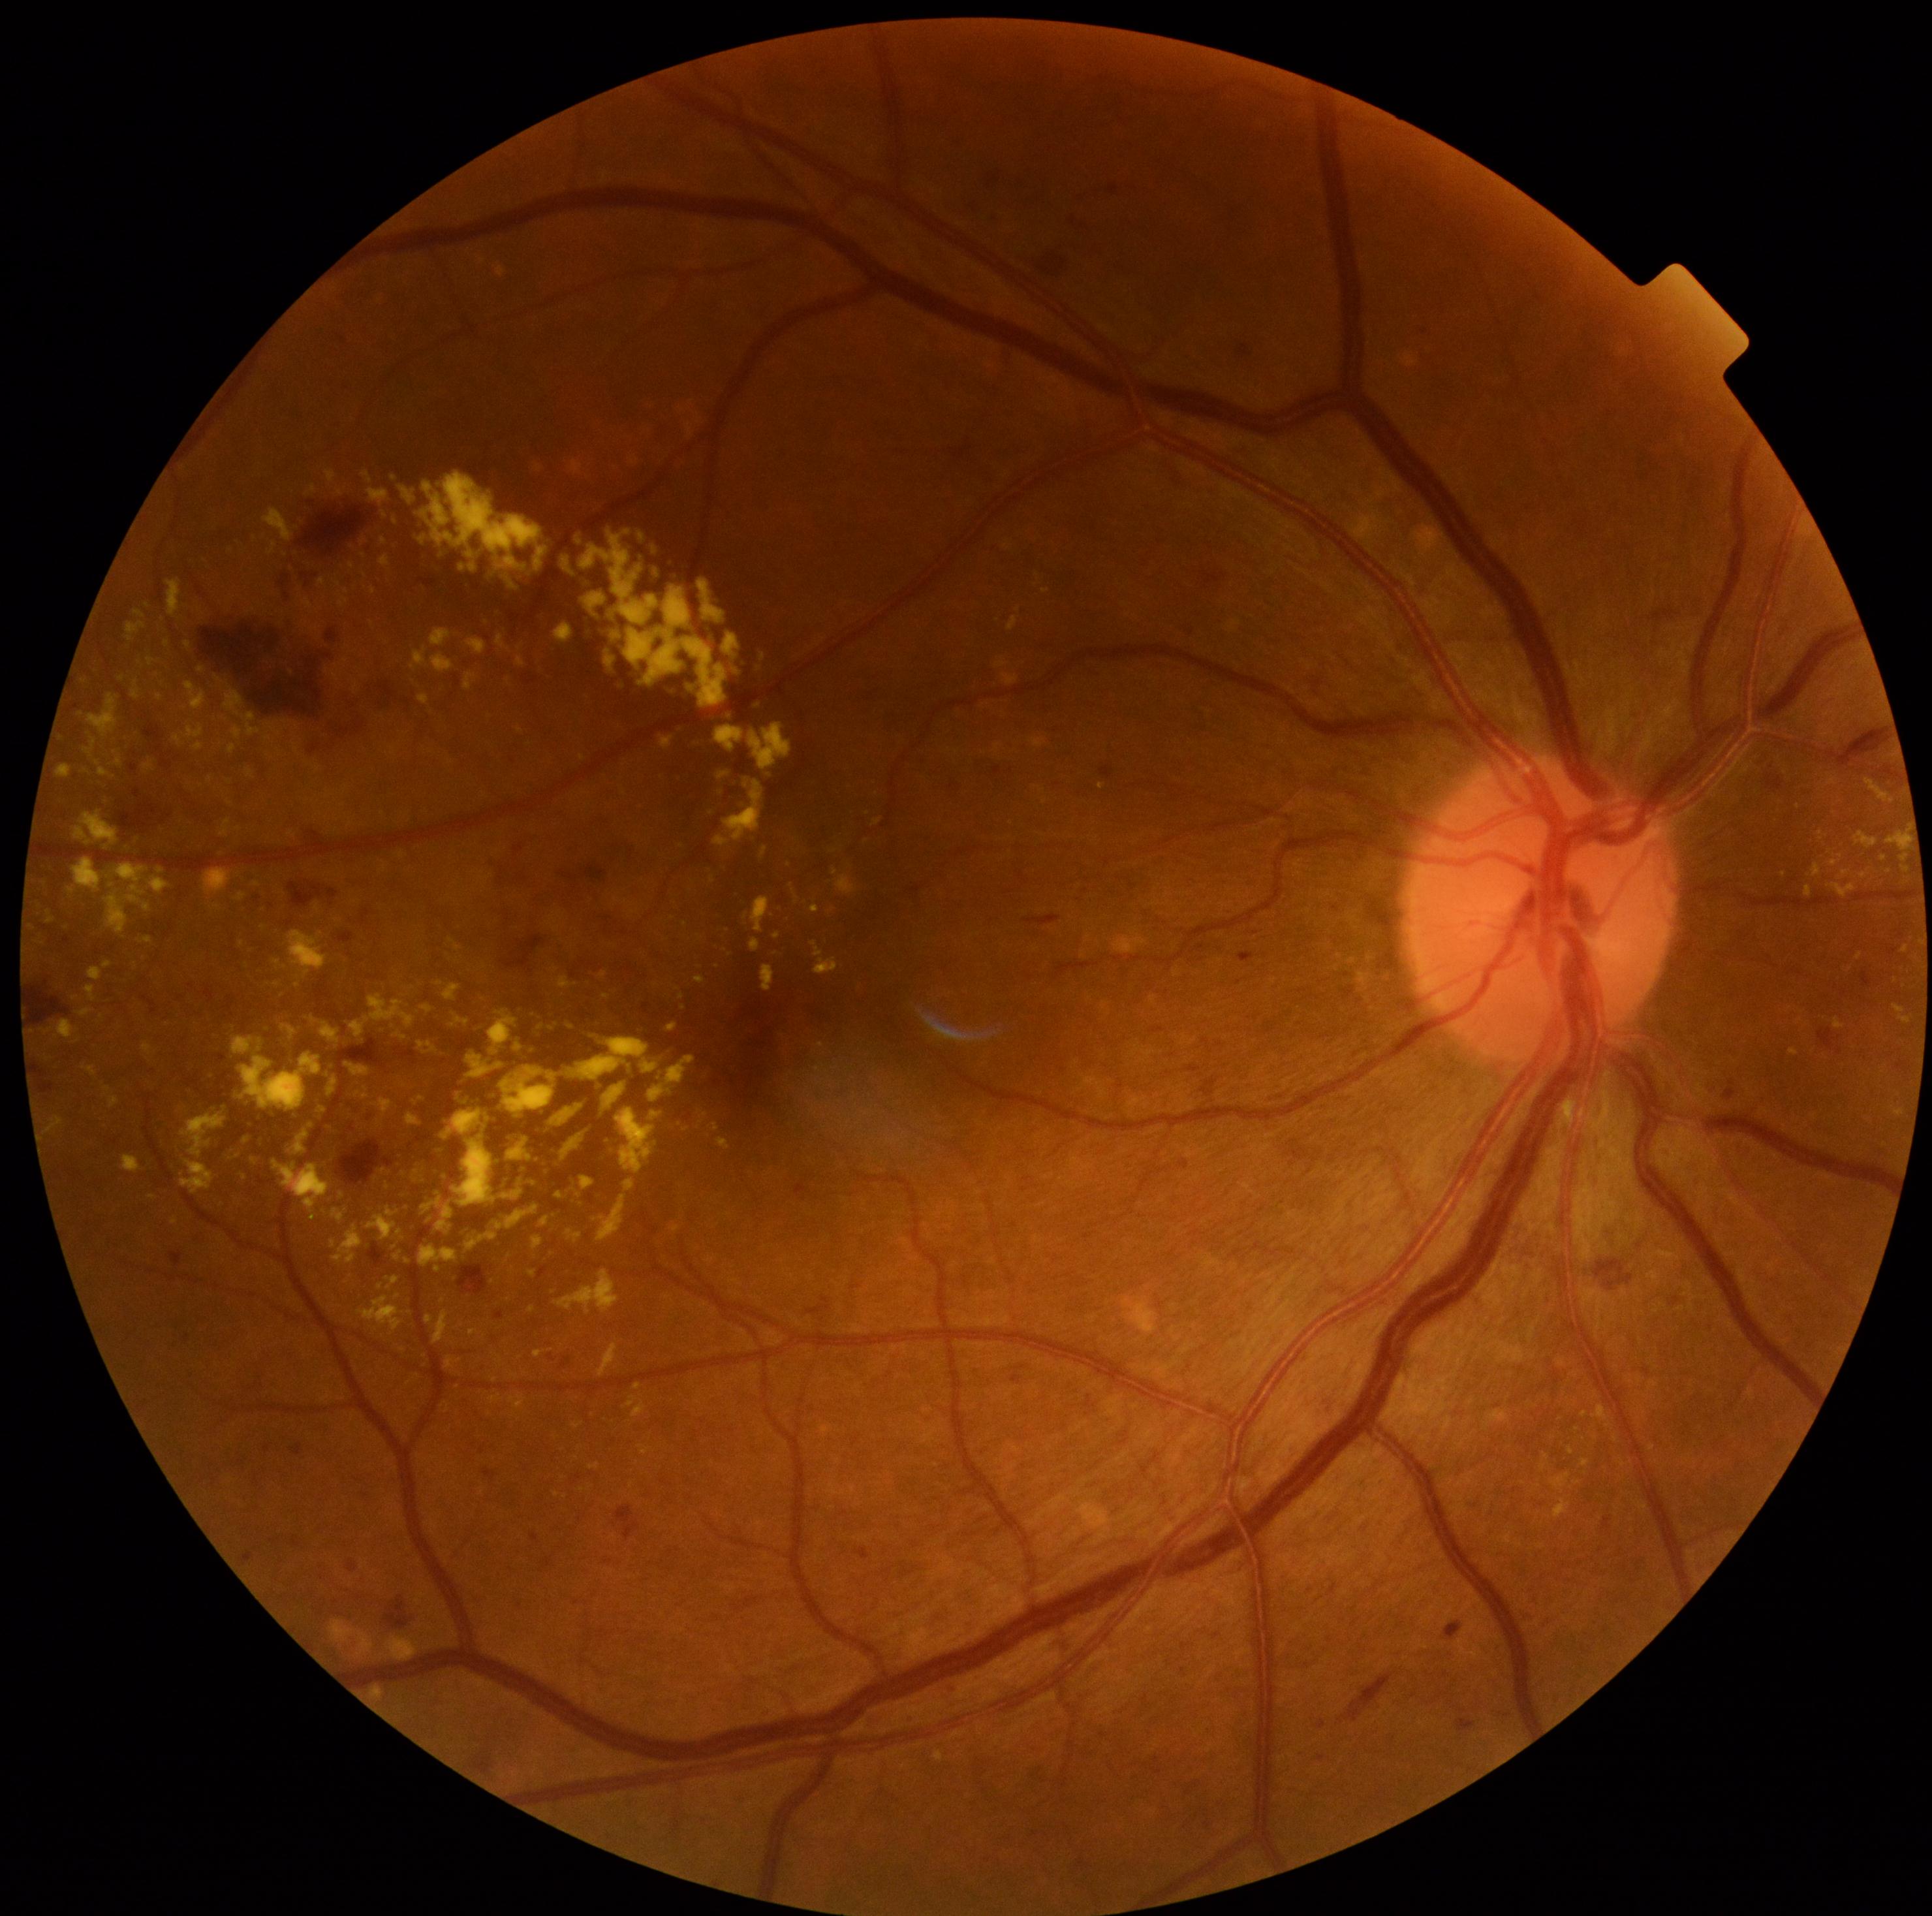 Diabetic retinopathy: 2
A subset of detected lesions:
* microaneurysms (more not shown): [left=264, top=1443, right=273, bottom=1453], [left=1446, top=1622, right=1461, bottom=1640], [left=1182, top=1644, right=1190, bottom=1649], [left=1187, top=1064, right=1200, bottom=1073], [left=522, top=672, right=538, bottom=685], [left=854, top=1547, right=870, bottom=1560], [left=326, top=628, right=339, bottom=642], [left=1313, top=680, right=1322, bottom=685], [left=339, top=932, right=354, bottom=943], [left=347, top=1560, right=358, bottom=1573], [left=613, top=1505, right=642, bottom=1541], [left=1673, top=1296, right=1681, bottom=1307], [left=420, top=576, right=438, bottom=589], [left=515, top=846, right=524, bottom=855], [left=1887, top=945, right=1900, bottom=956]
* soft exudates: absent
* hard exudates (more not shown): [left=717, top=1139, right=730, bottom=1150], [left=596, top=1195, right=626, bottom=1242], [left=464, top=671, right=478, bottom=691], [left=425, top=1316, right=434, bottom=1323], [left=790, top=885, right=798, bottom=898], [left=582, top=790, right=591, bottom=798], [left=1887, top=833, right=1909, bottom=851], [left=600, top=971, right=608, bottom=978], [left=364, top=1000, right=695, bottom=1268], [left=1839, top=870, right=1850, bottom=880], [left=165, top=580, right=182, bottom=619], [left=1835, top=1020, right=1844, bottom=1029], [left=356, top=682, right=360, bottom=693], [left=132, top=680, right=142, bottom=701]
* Hard exudates (small, approximate centers) near x=297 y=727, x=713 y=880, x=201 y=669, x=1860 y=957, x=674 y=918, x=415 y=1103
* hemorrhages (more not shown): [left=37, top=1064, right=55, bottom=1094], [left=289, top=881, right=339, bottom=907], [left=309, top=743, right=320, bottom=755], [left=502, top=935, right=544, bottom=977], [left=1339, top=1674, right=1395, bottom=1723], [left=203, top=619, right=330, bottom=725], [left=1025, top=915, right=1061, bottom=926], [left=386, top=1595, right=411, bottom=1629], [left=117, top=798, right=163, bottom=834], [left=460, top=460, right=542, bottom=516], [left=377, top=682, right=397, bottom=706], [left=335, top=729, right=352, bottom=738]